FOV: 45 degrees — 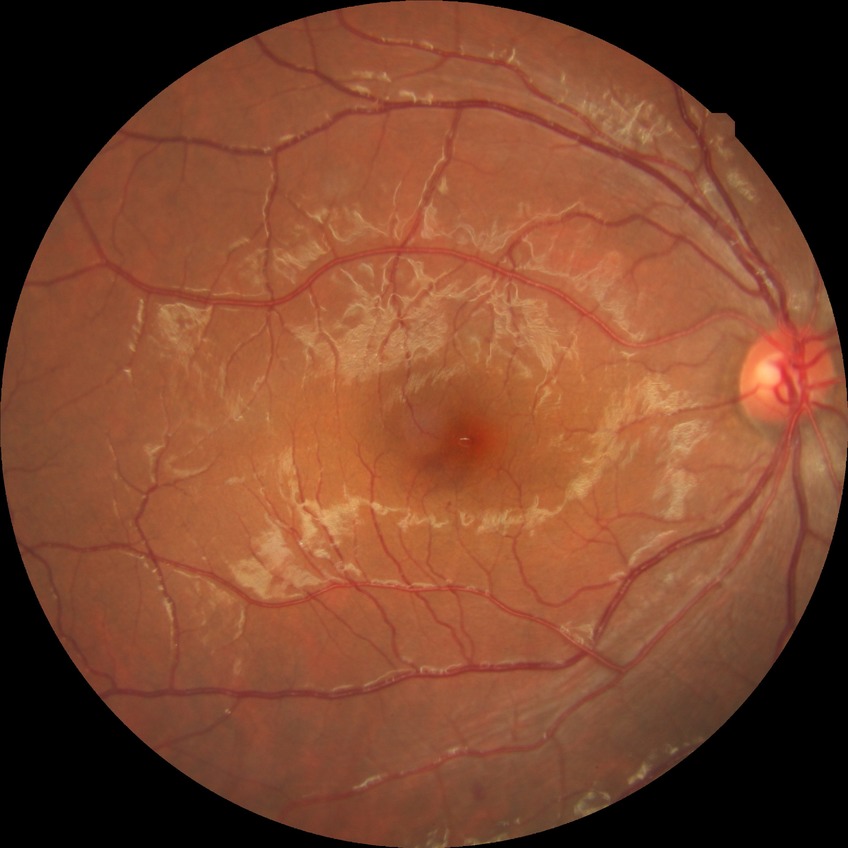 retinopathy grade: simple diabetic retinopathy.